Captured after pupil dilation · FOV: 50 degrees · 2361 x 1568 pixels · retinal fundus photograph · macula-centered field — 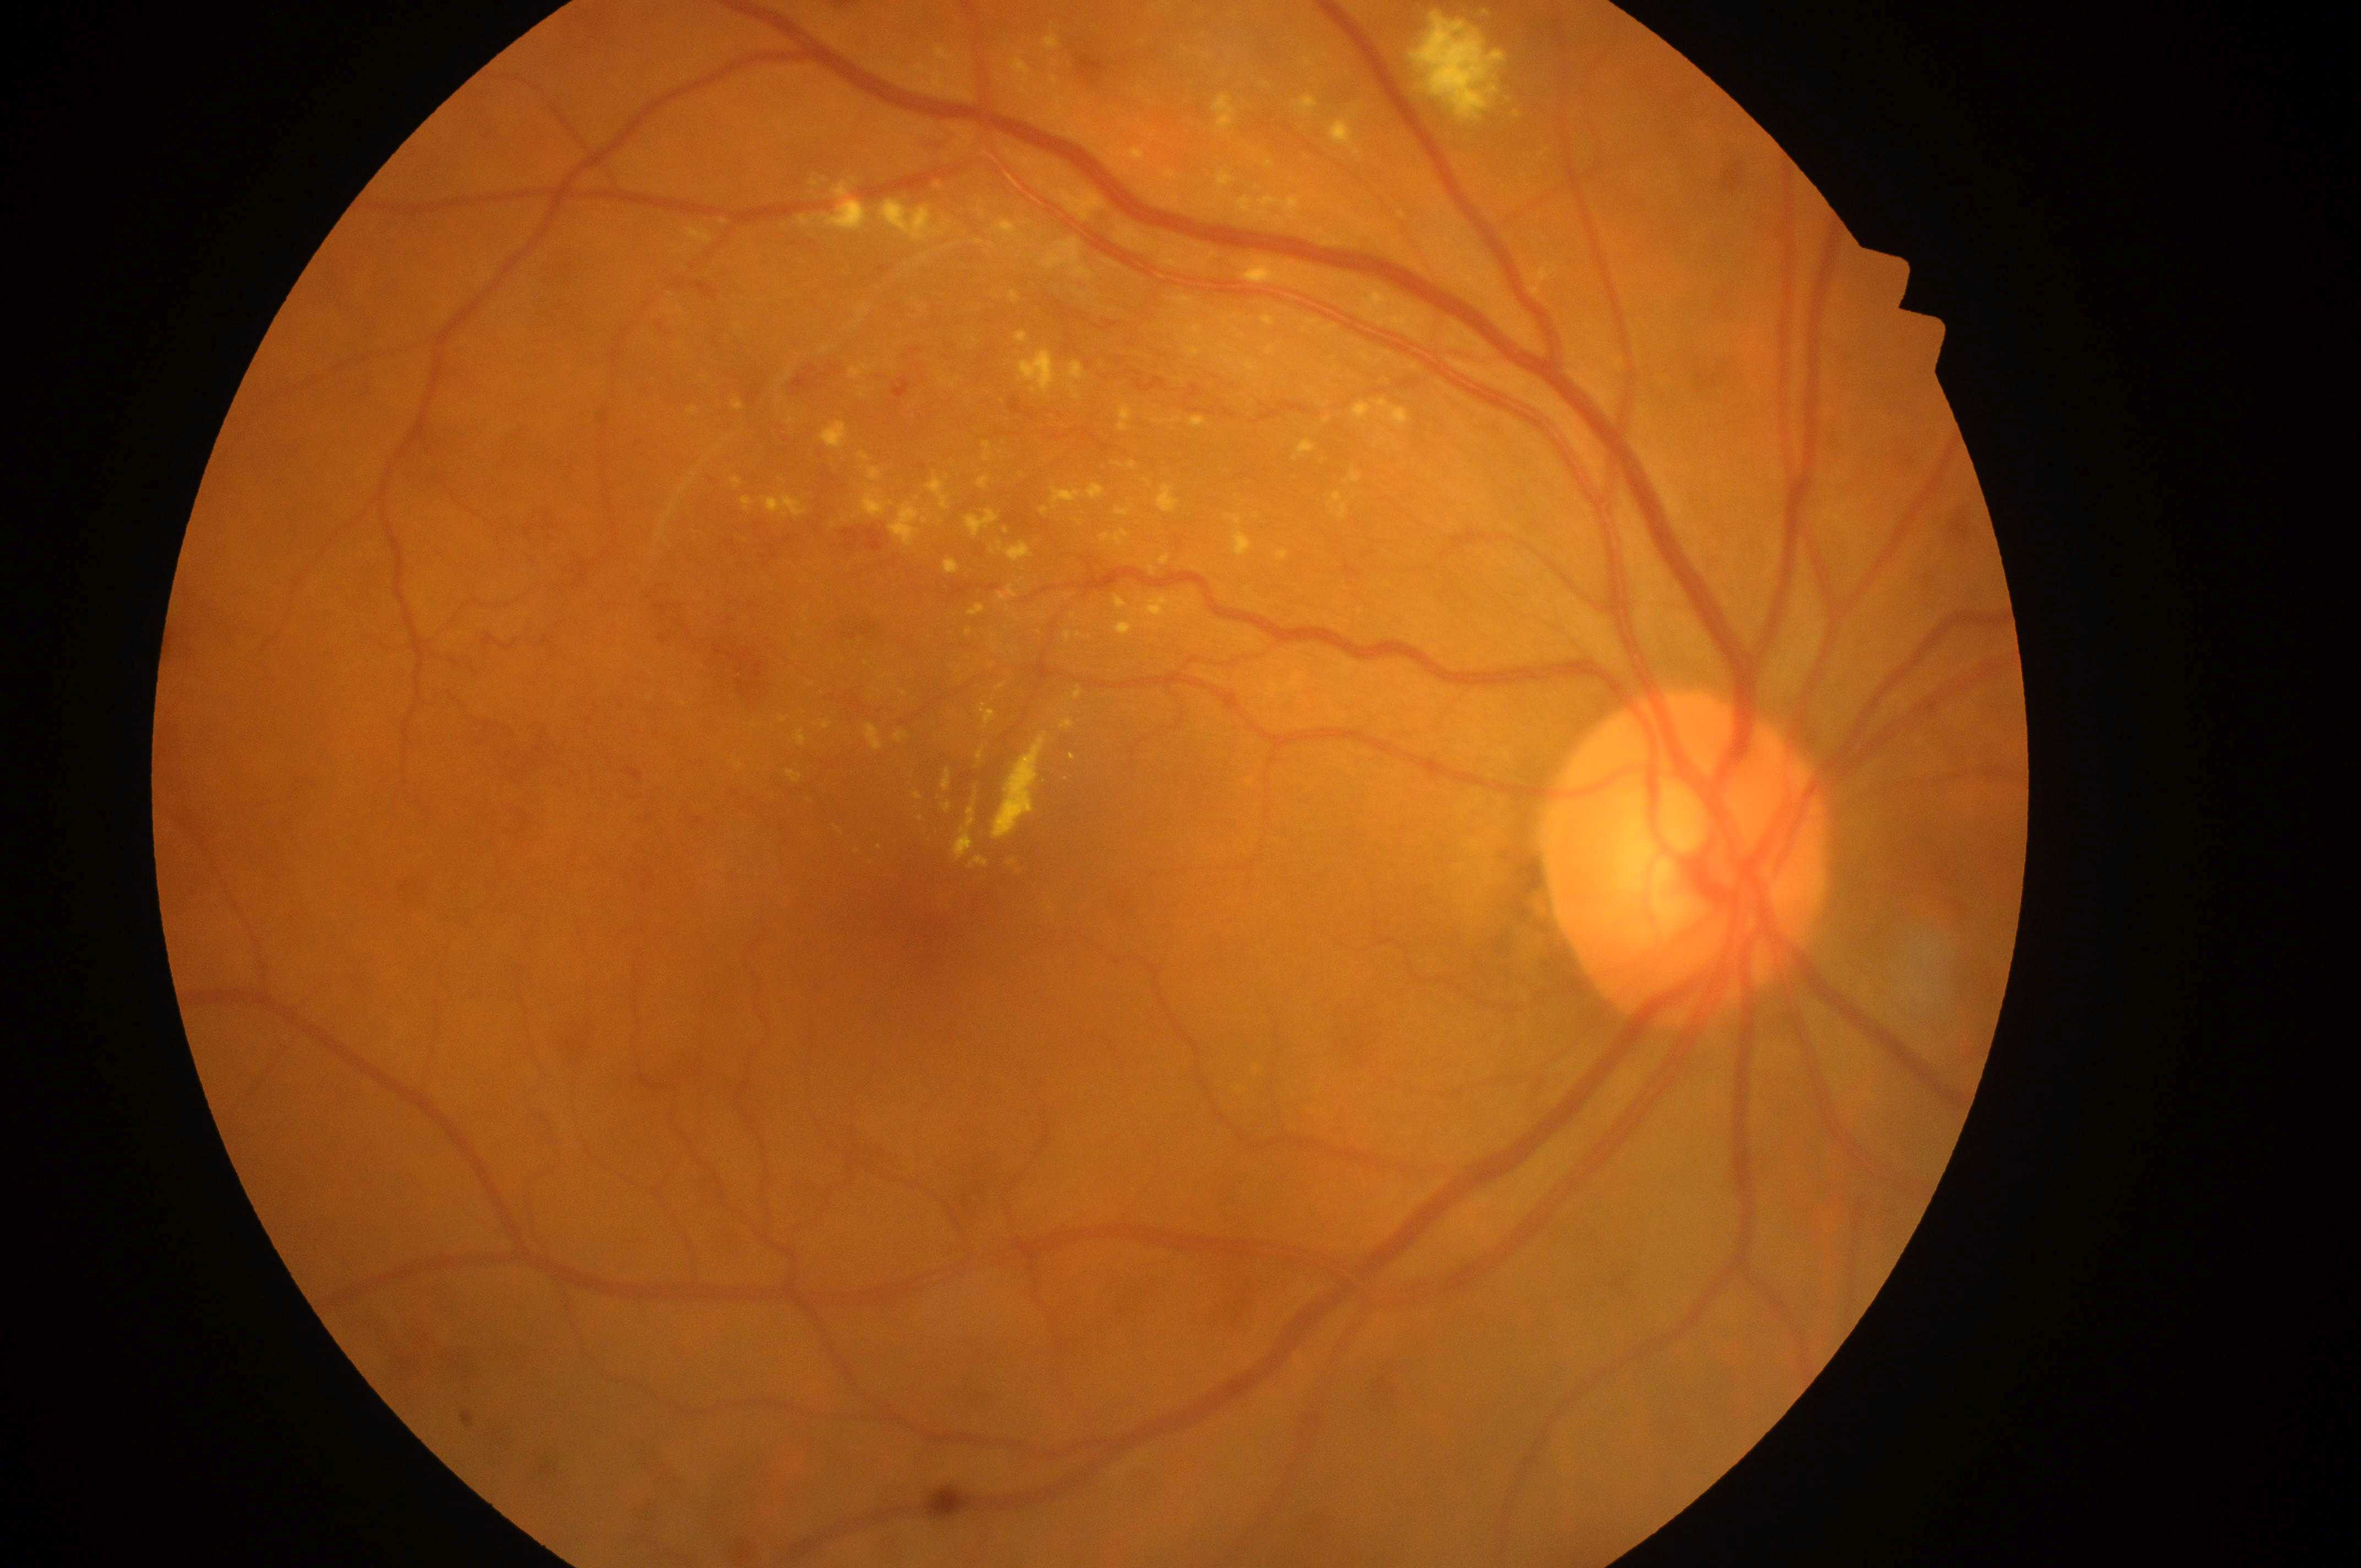
Q: Where is the fovea?
A: (936, 905)
Q: Optic disc center?
A: (1689, 866)
Q: DR stage?
A: severe non-proliferative diabetic retinopathy (grade 3)
Q: What is the DME risk grade?
A: grade 2 (high risk)
Q: Right or left eye?
A: the right eye